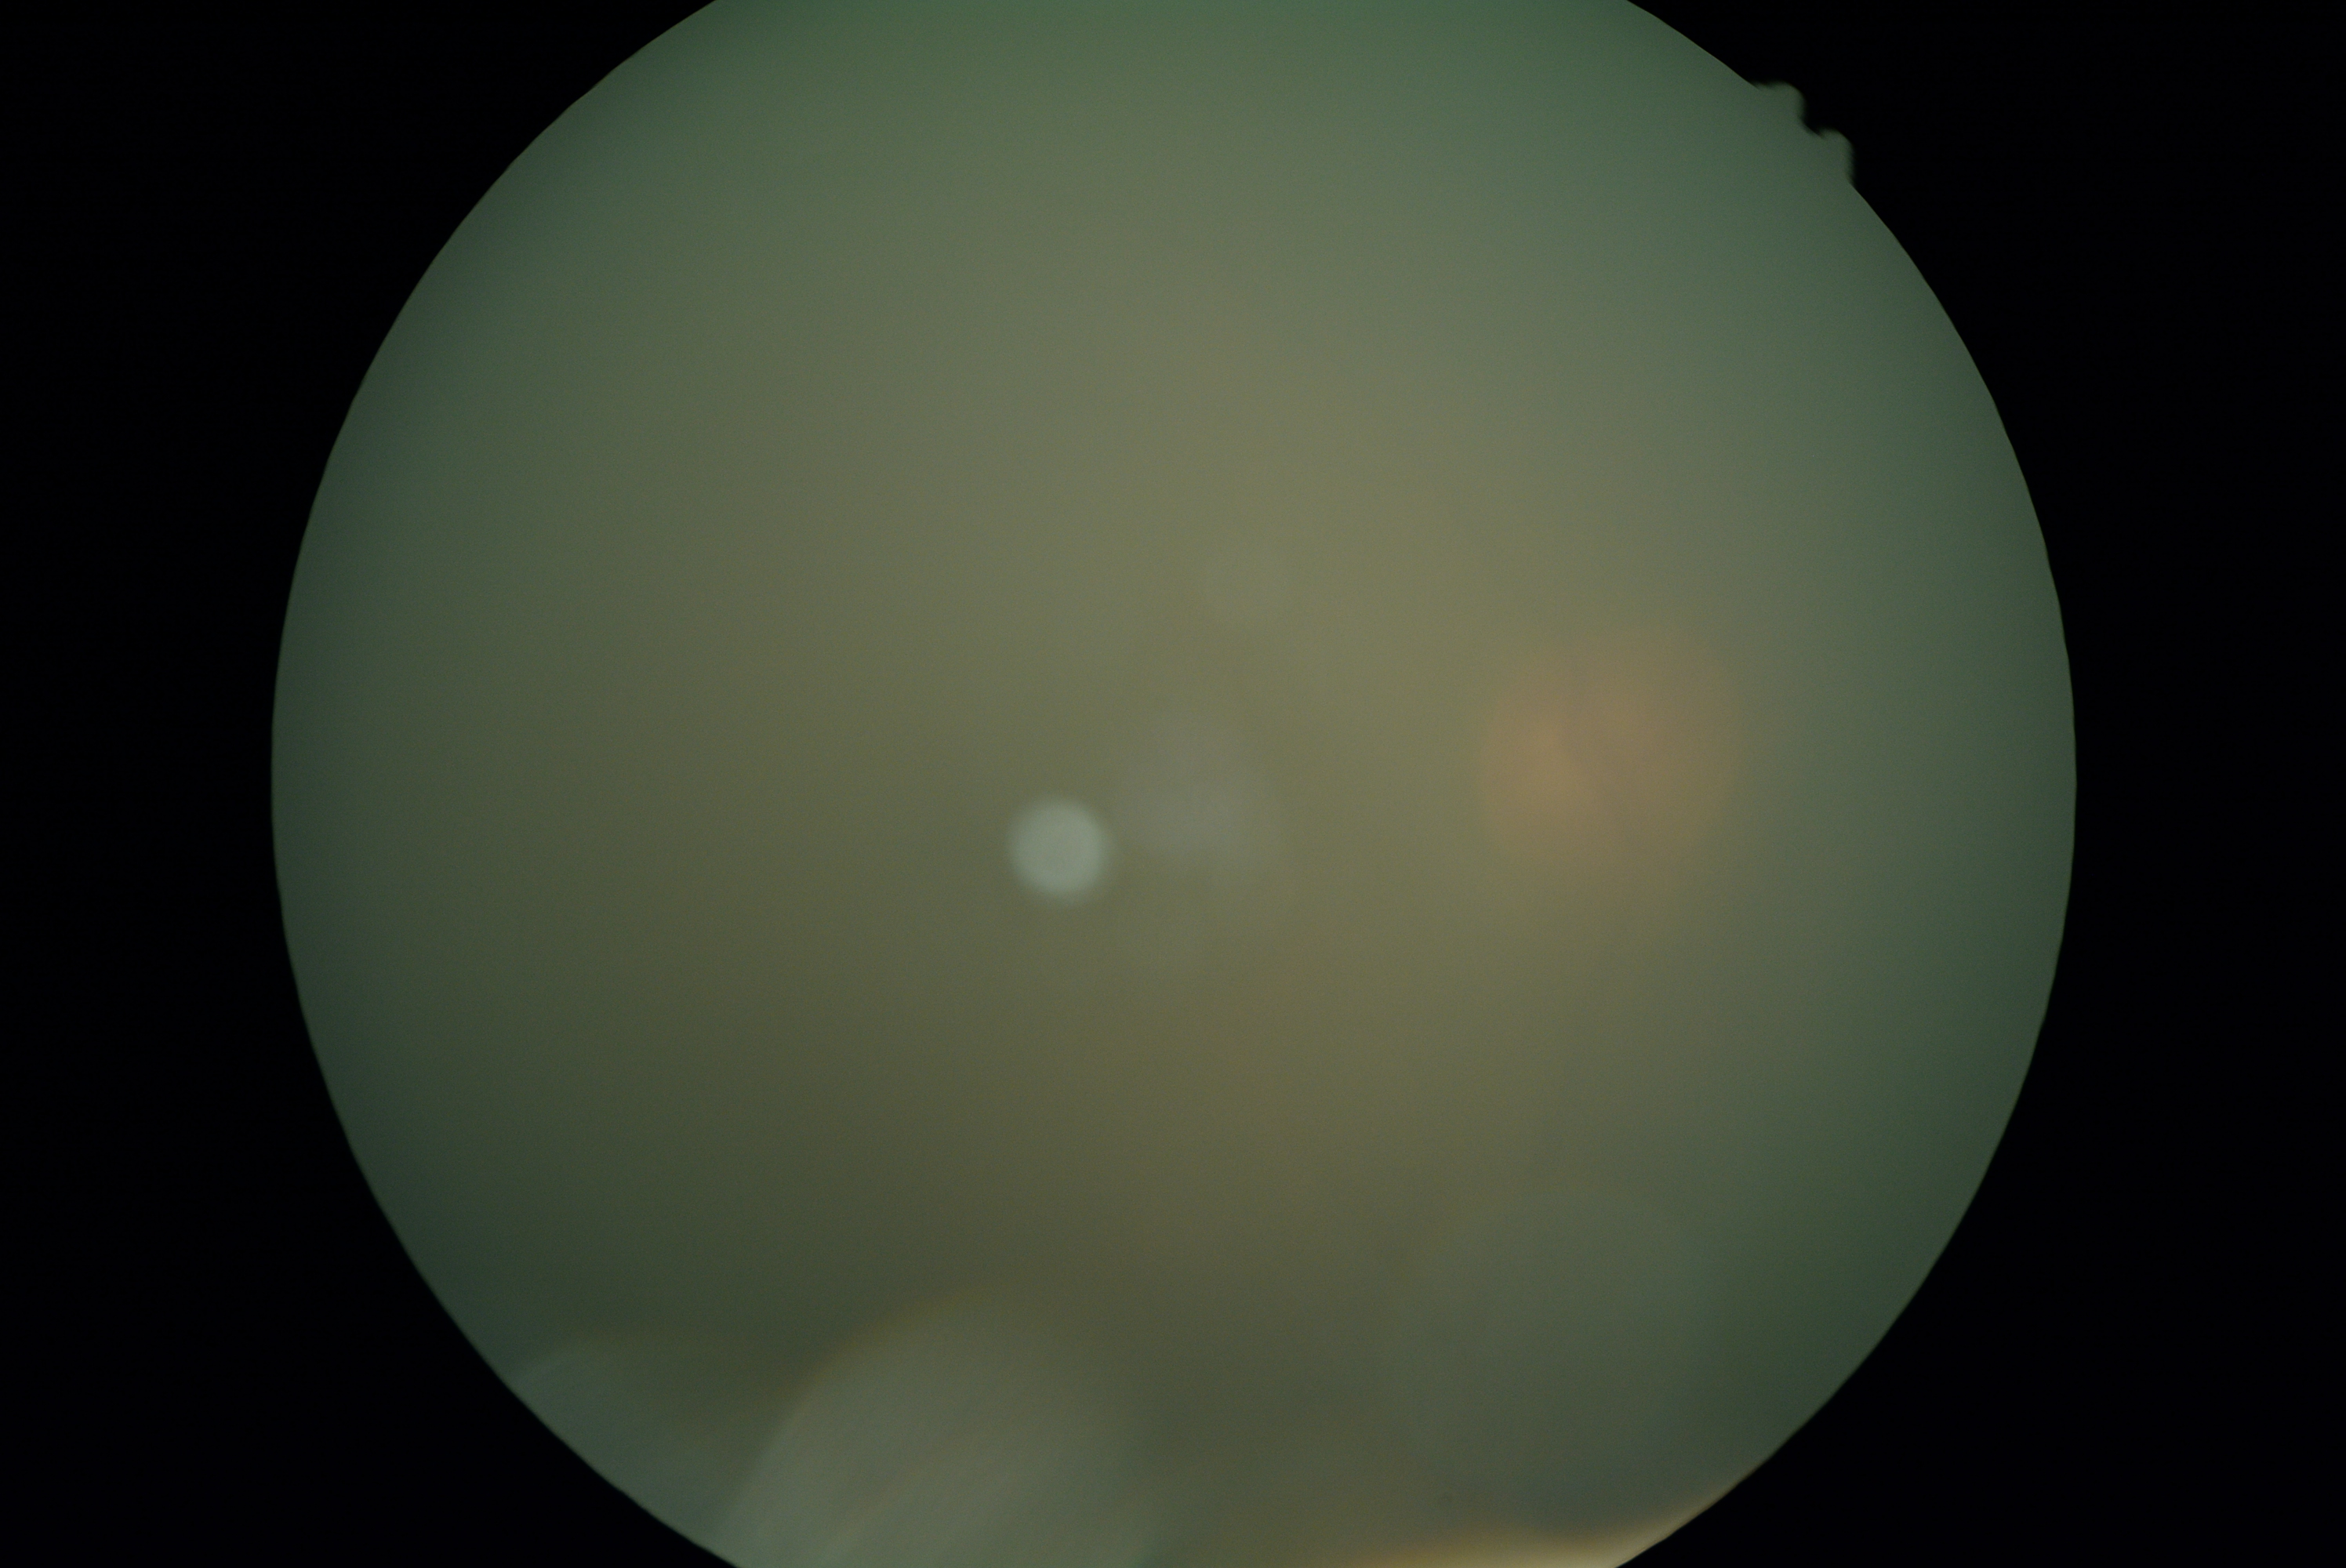
dr_grade: ungradable due to poor image quality
quality: insufficient